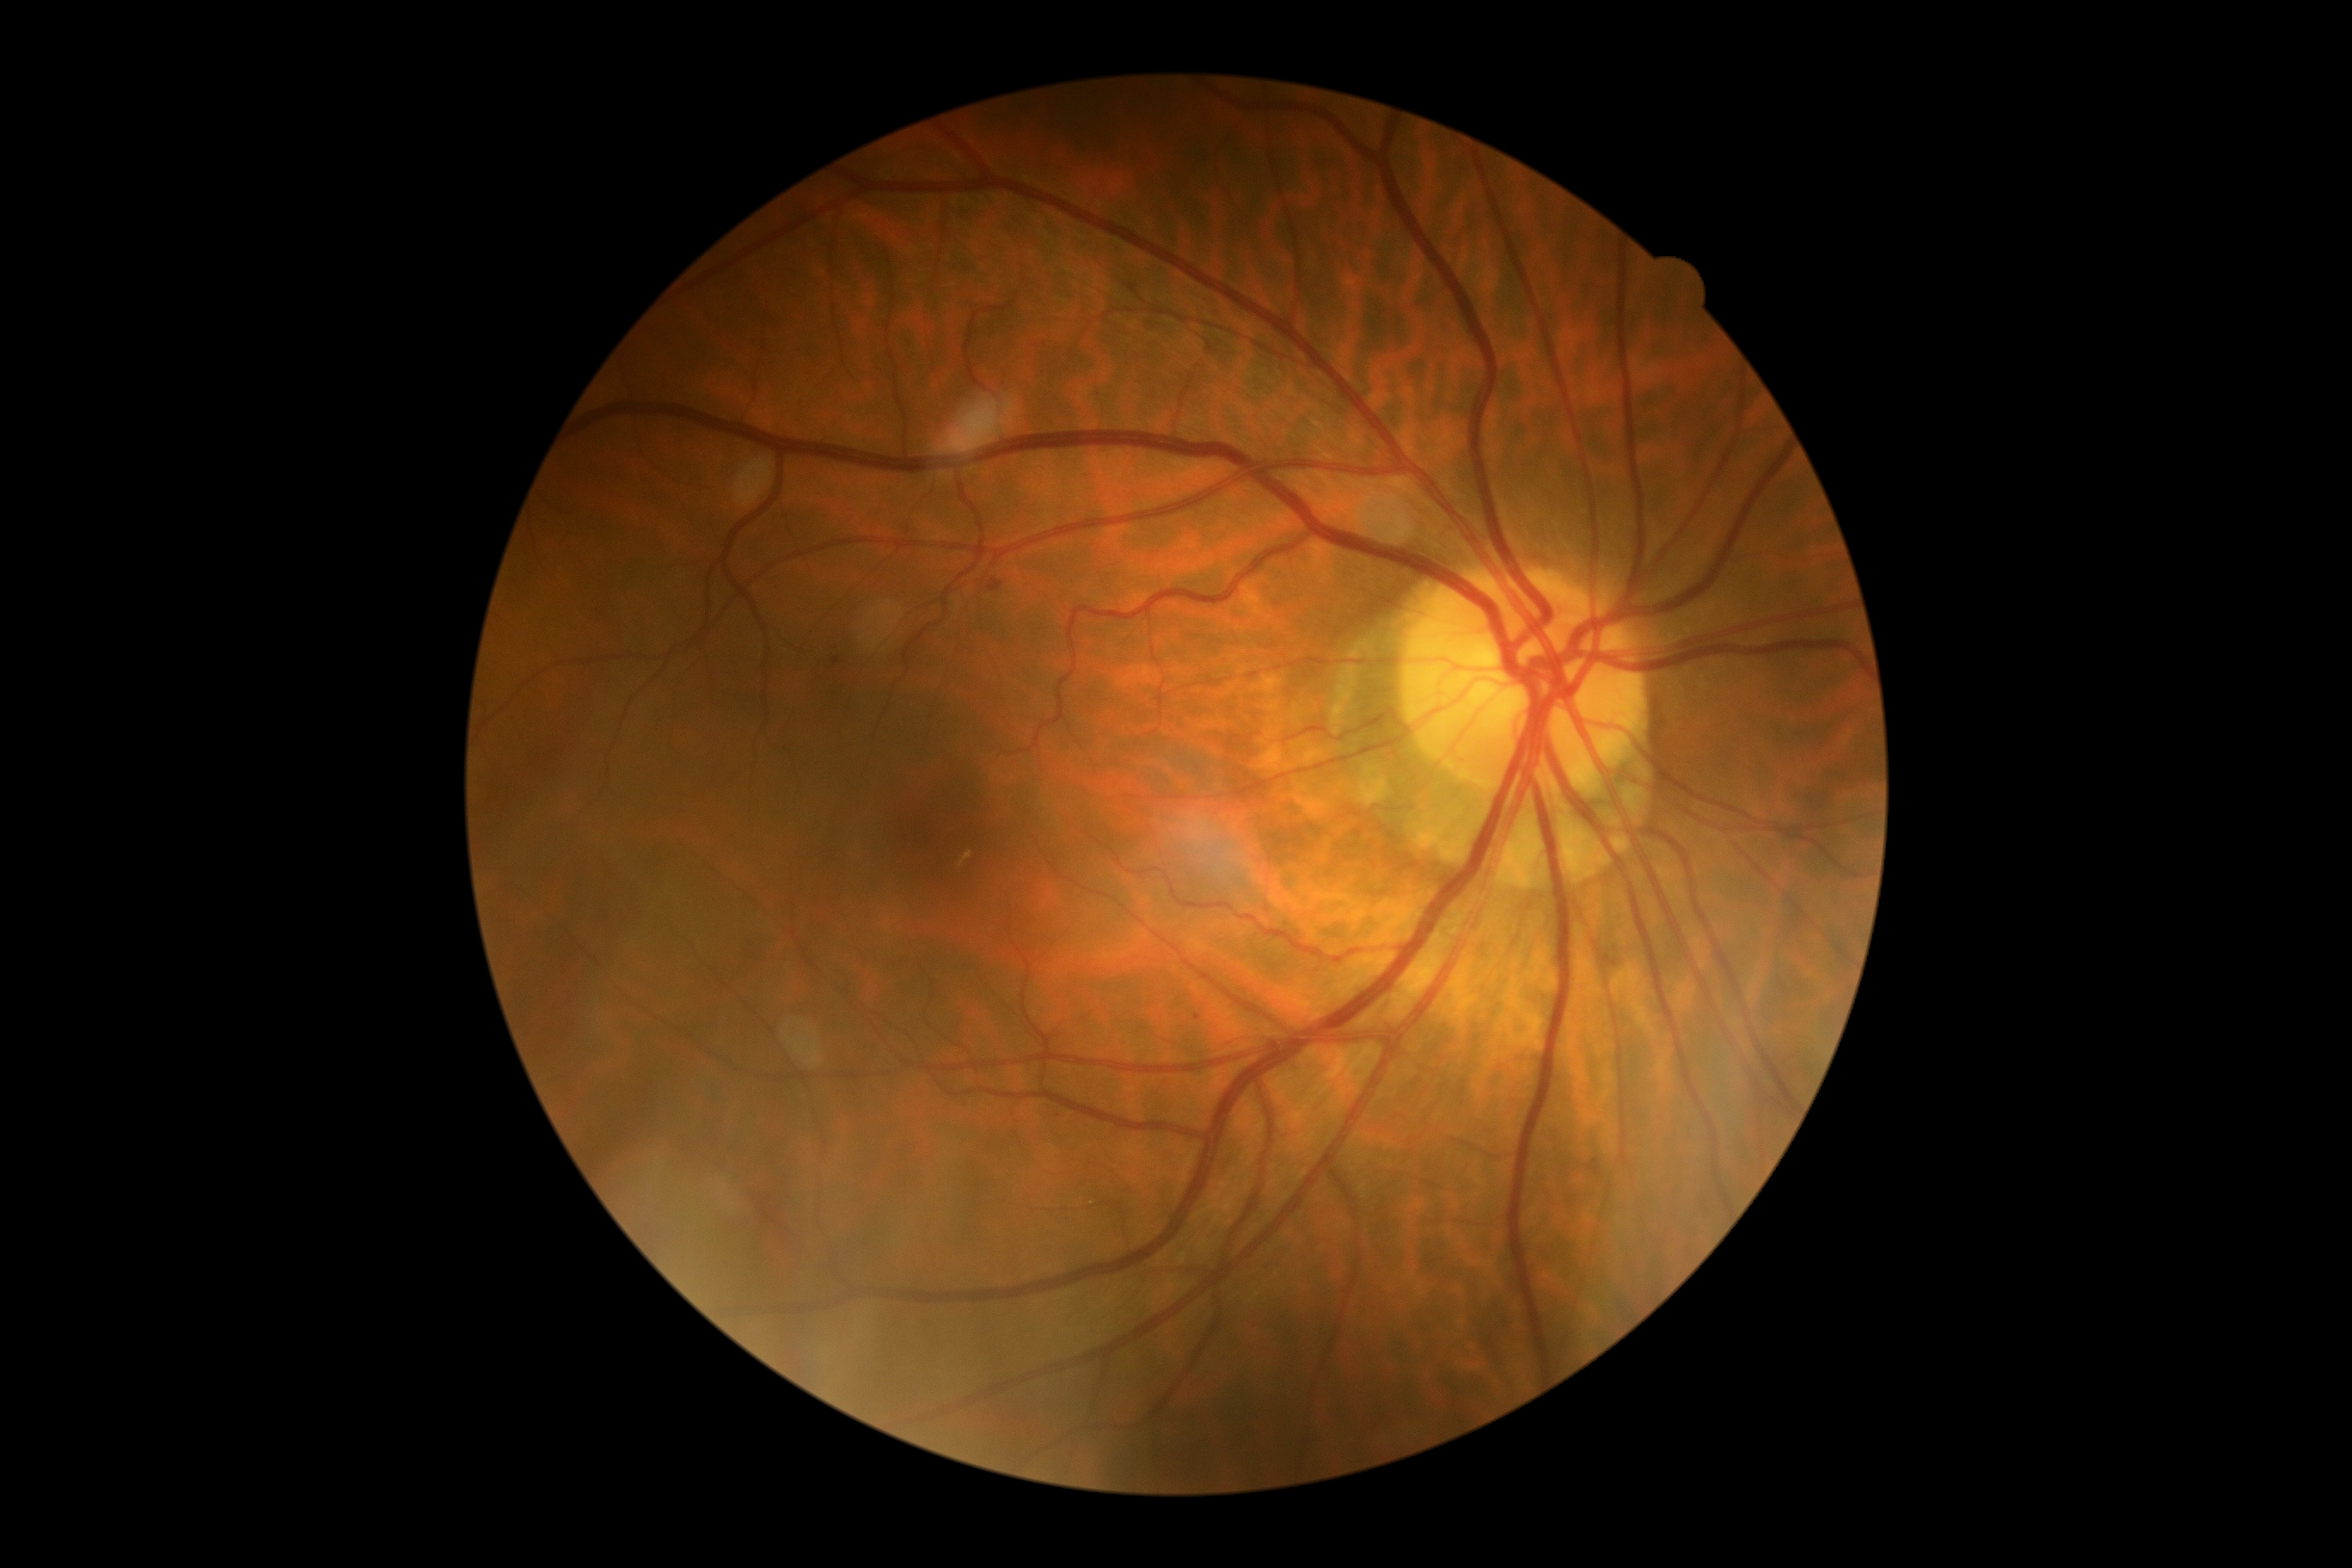 Retinopathy grade is 2/4.